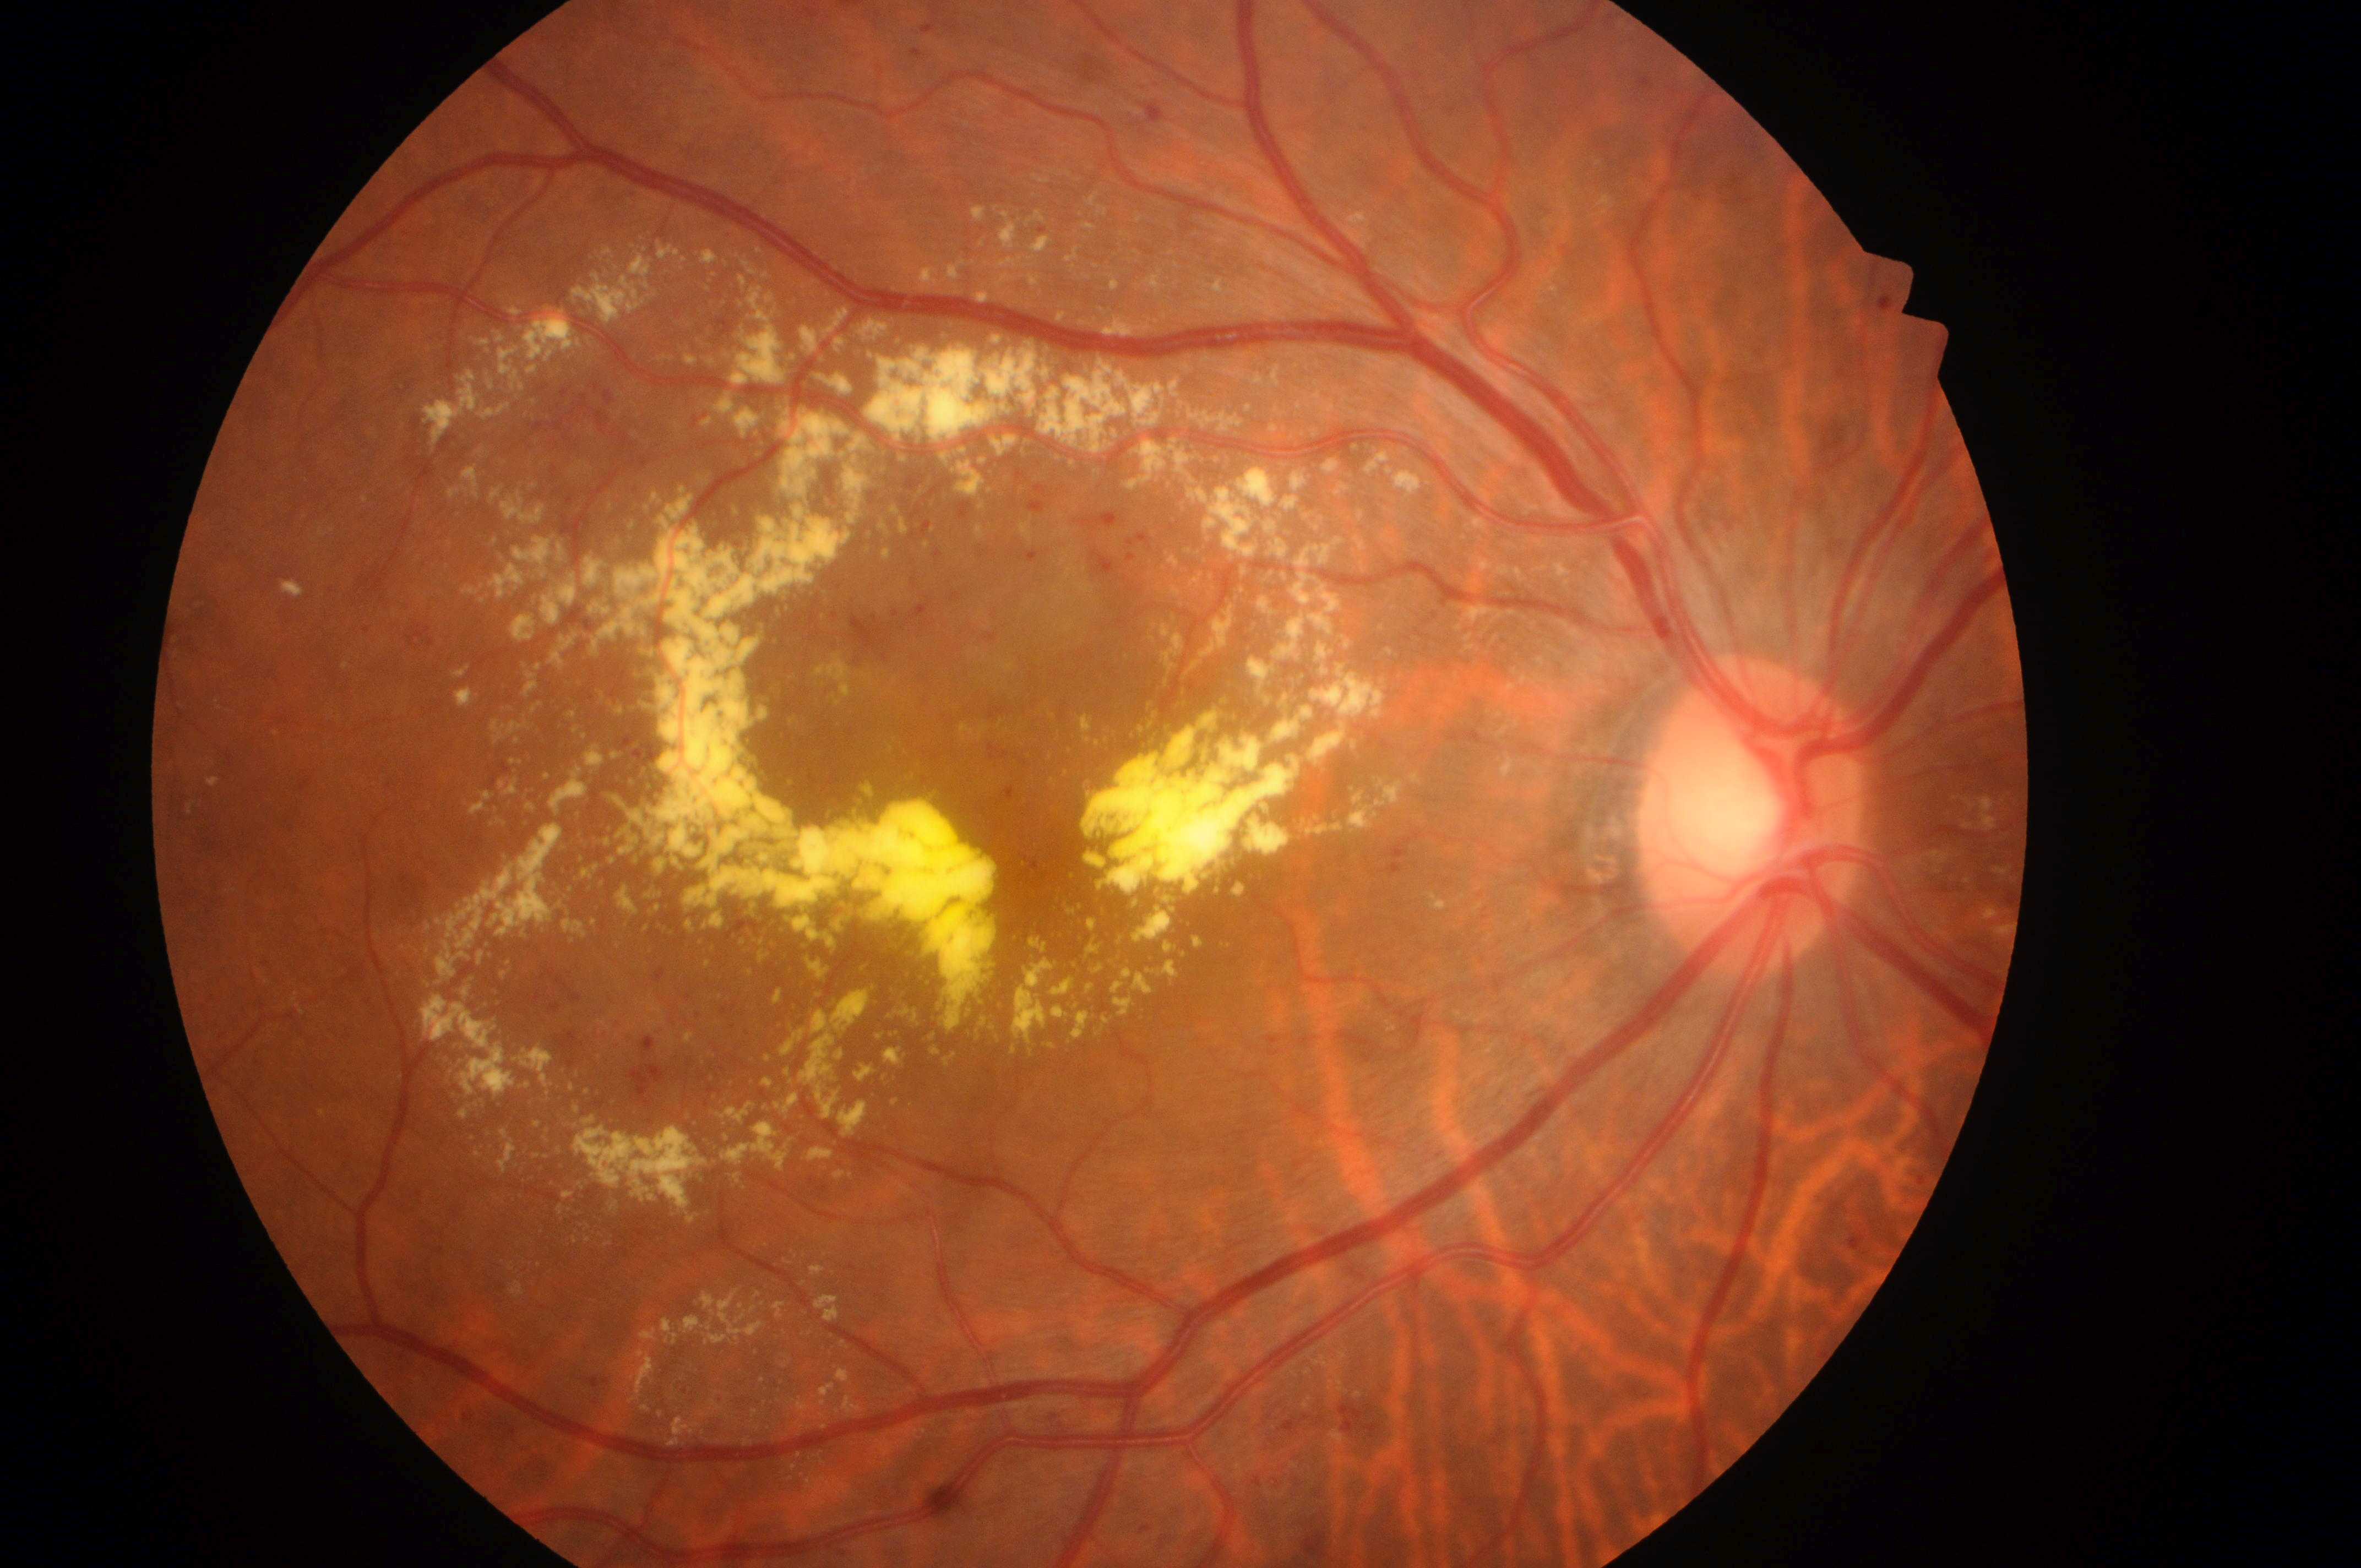 | field | value |
|---|---|
| laterality | right |
| diabetic macular edema (DME) | grade 2 (high risk) — hard exudates within one disc diameter of the macula center |
| diabetic retinopathy (DR) | grade 2 (moderate NPDR) — more than just microaneurysms but less than severe NPDR |
| fovea | (1033,862) |
| optic disk | (1747,831) |